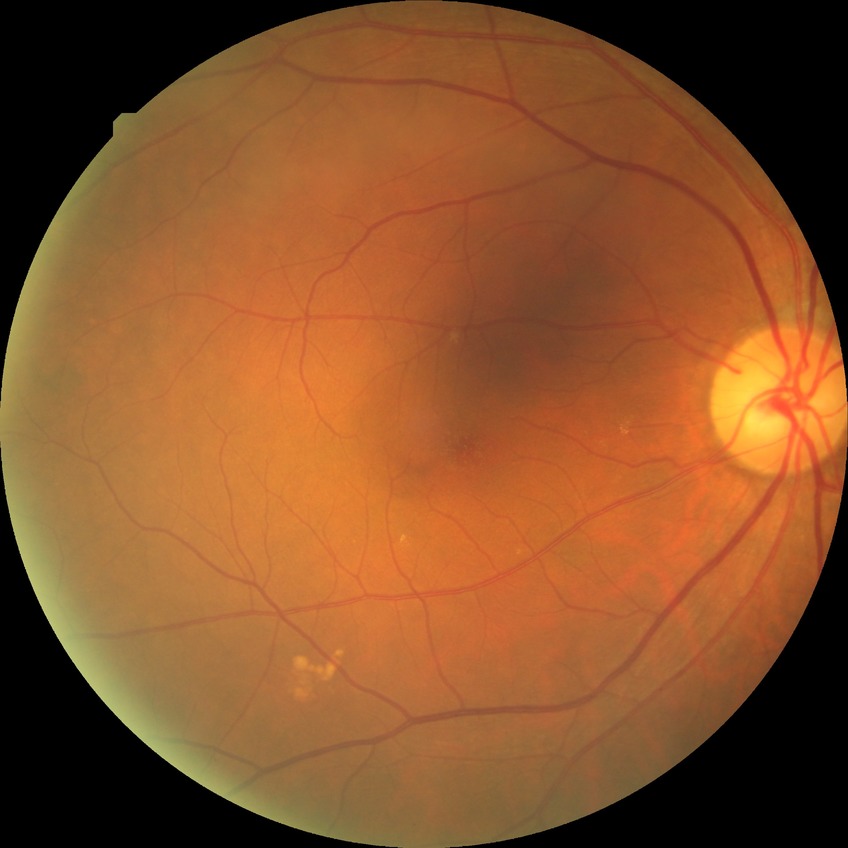 retinopathy grade: no diabetic retinopathy.